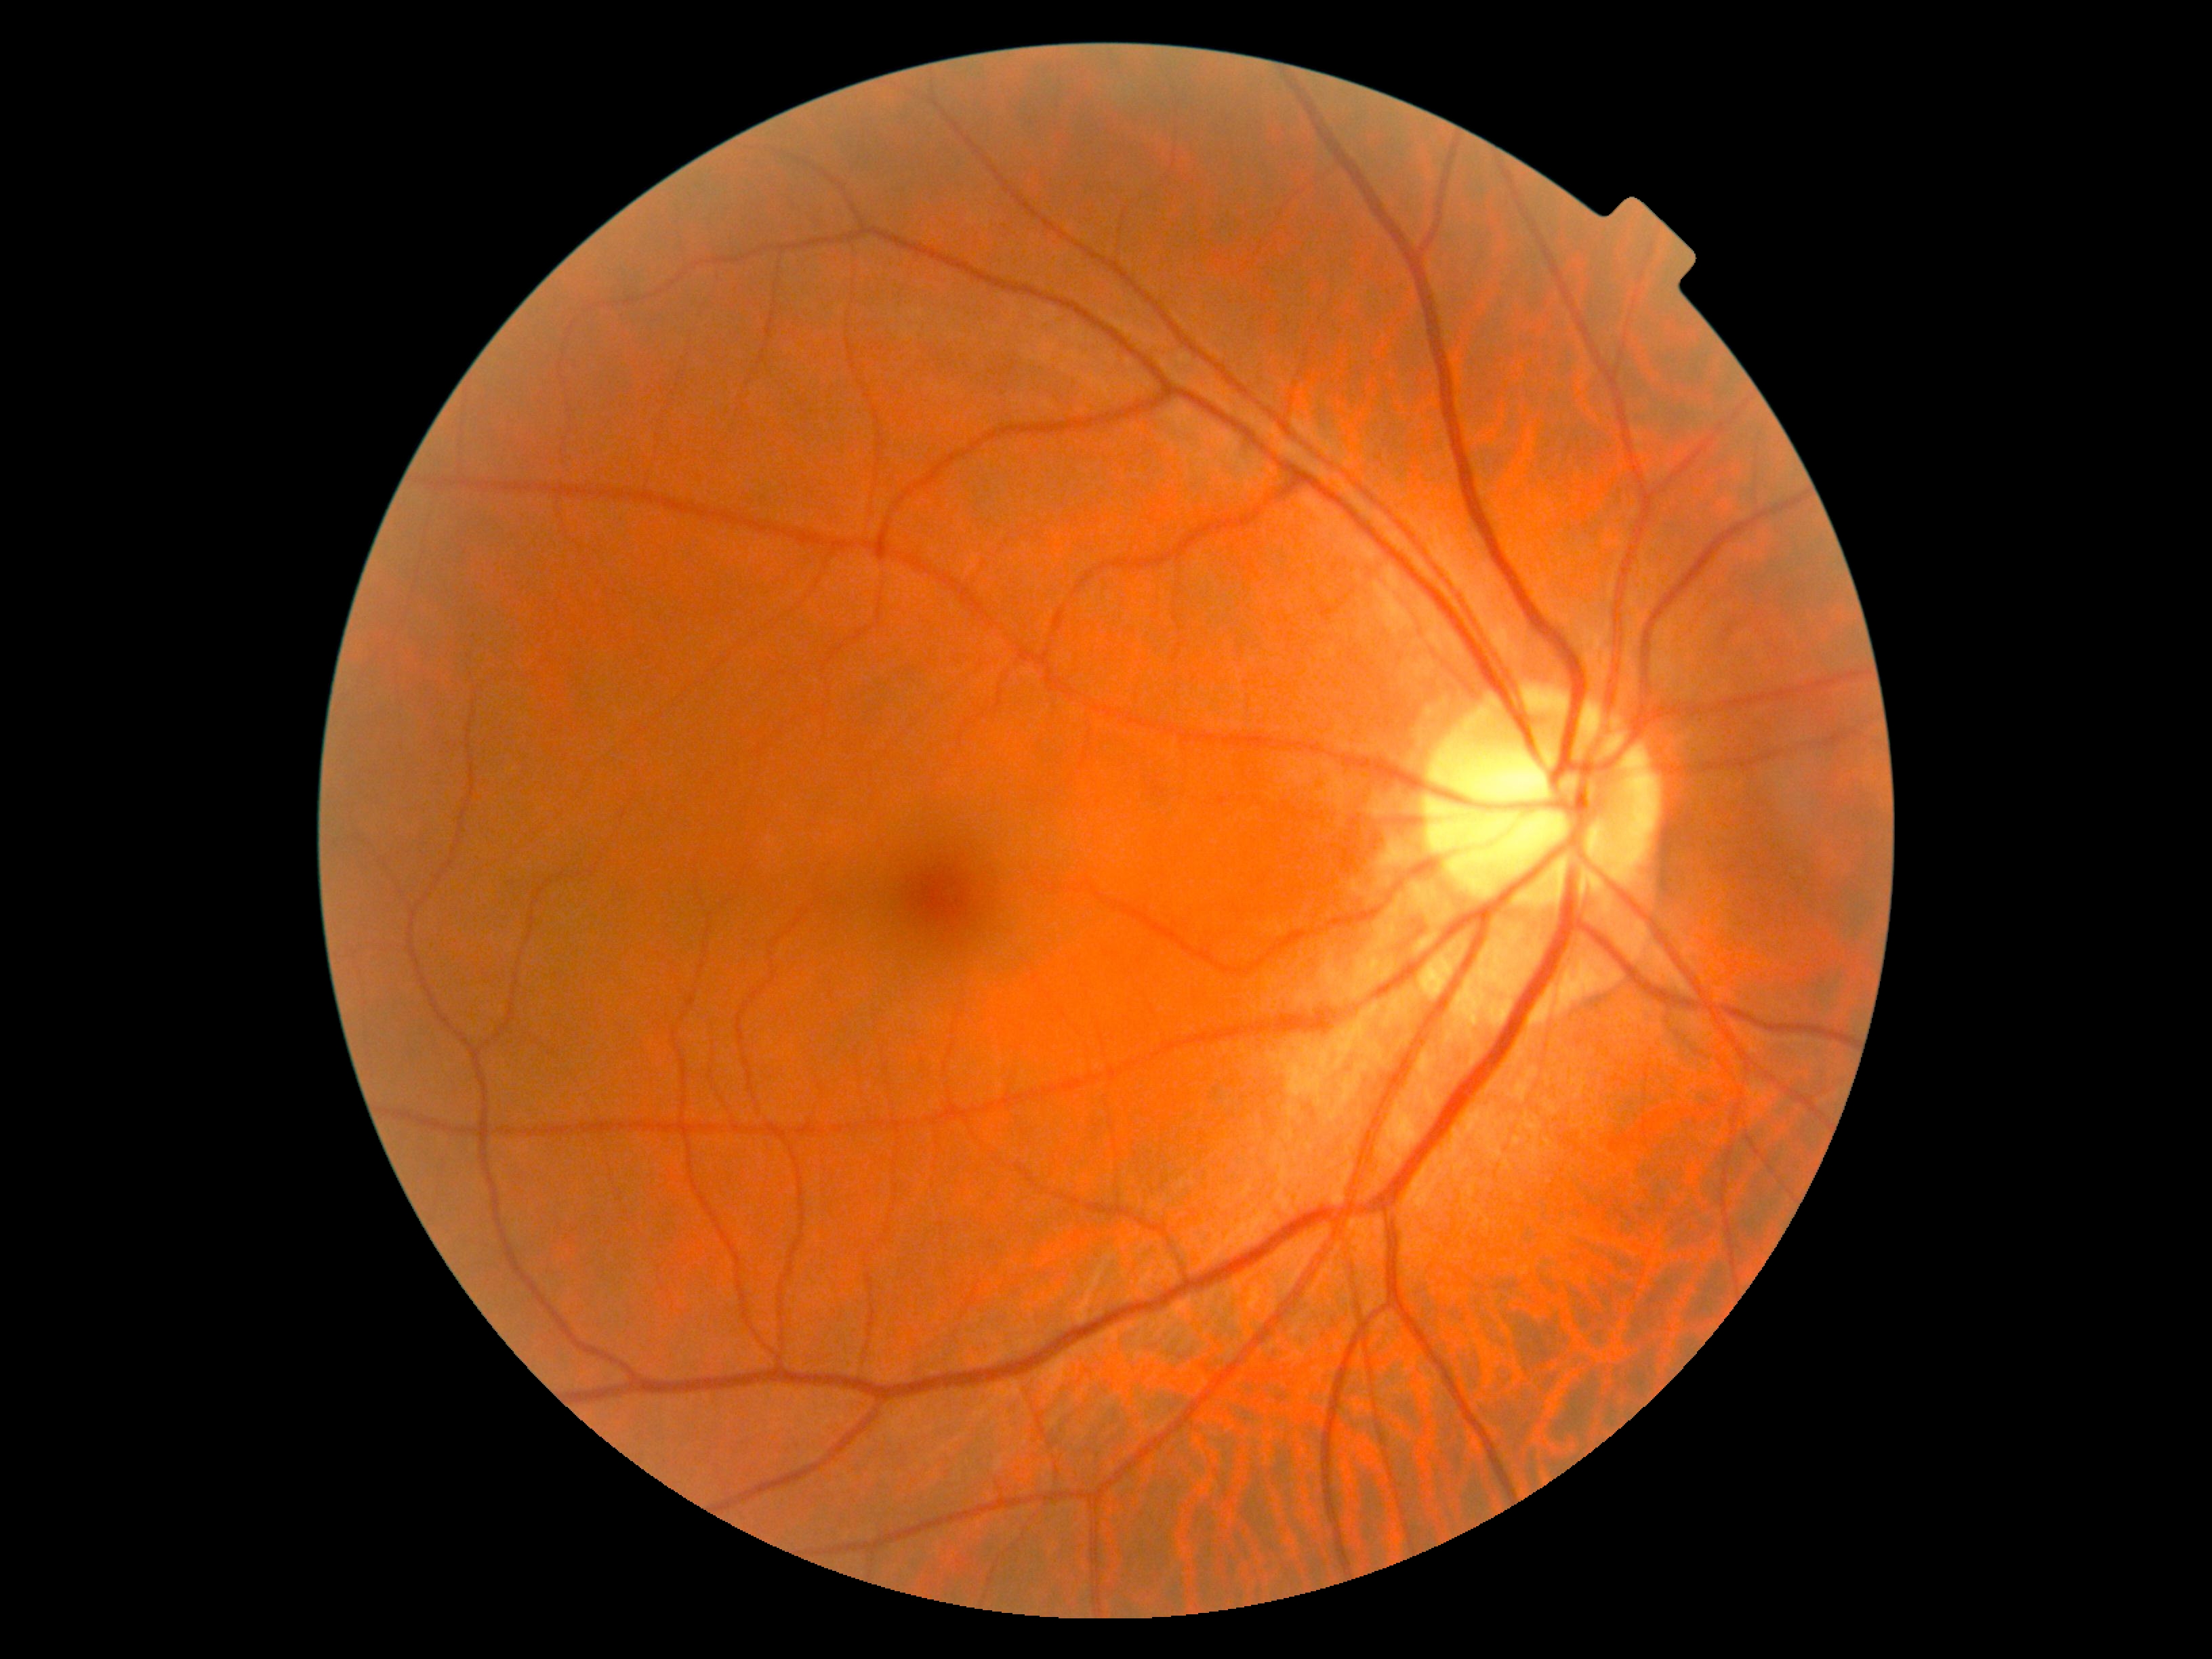 No DR findings. DR stage: 0/4 — no visible signs of diabetic retinopathy.